CFP. Image size 2184x1682:
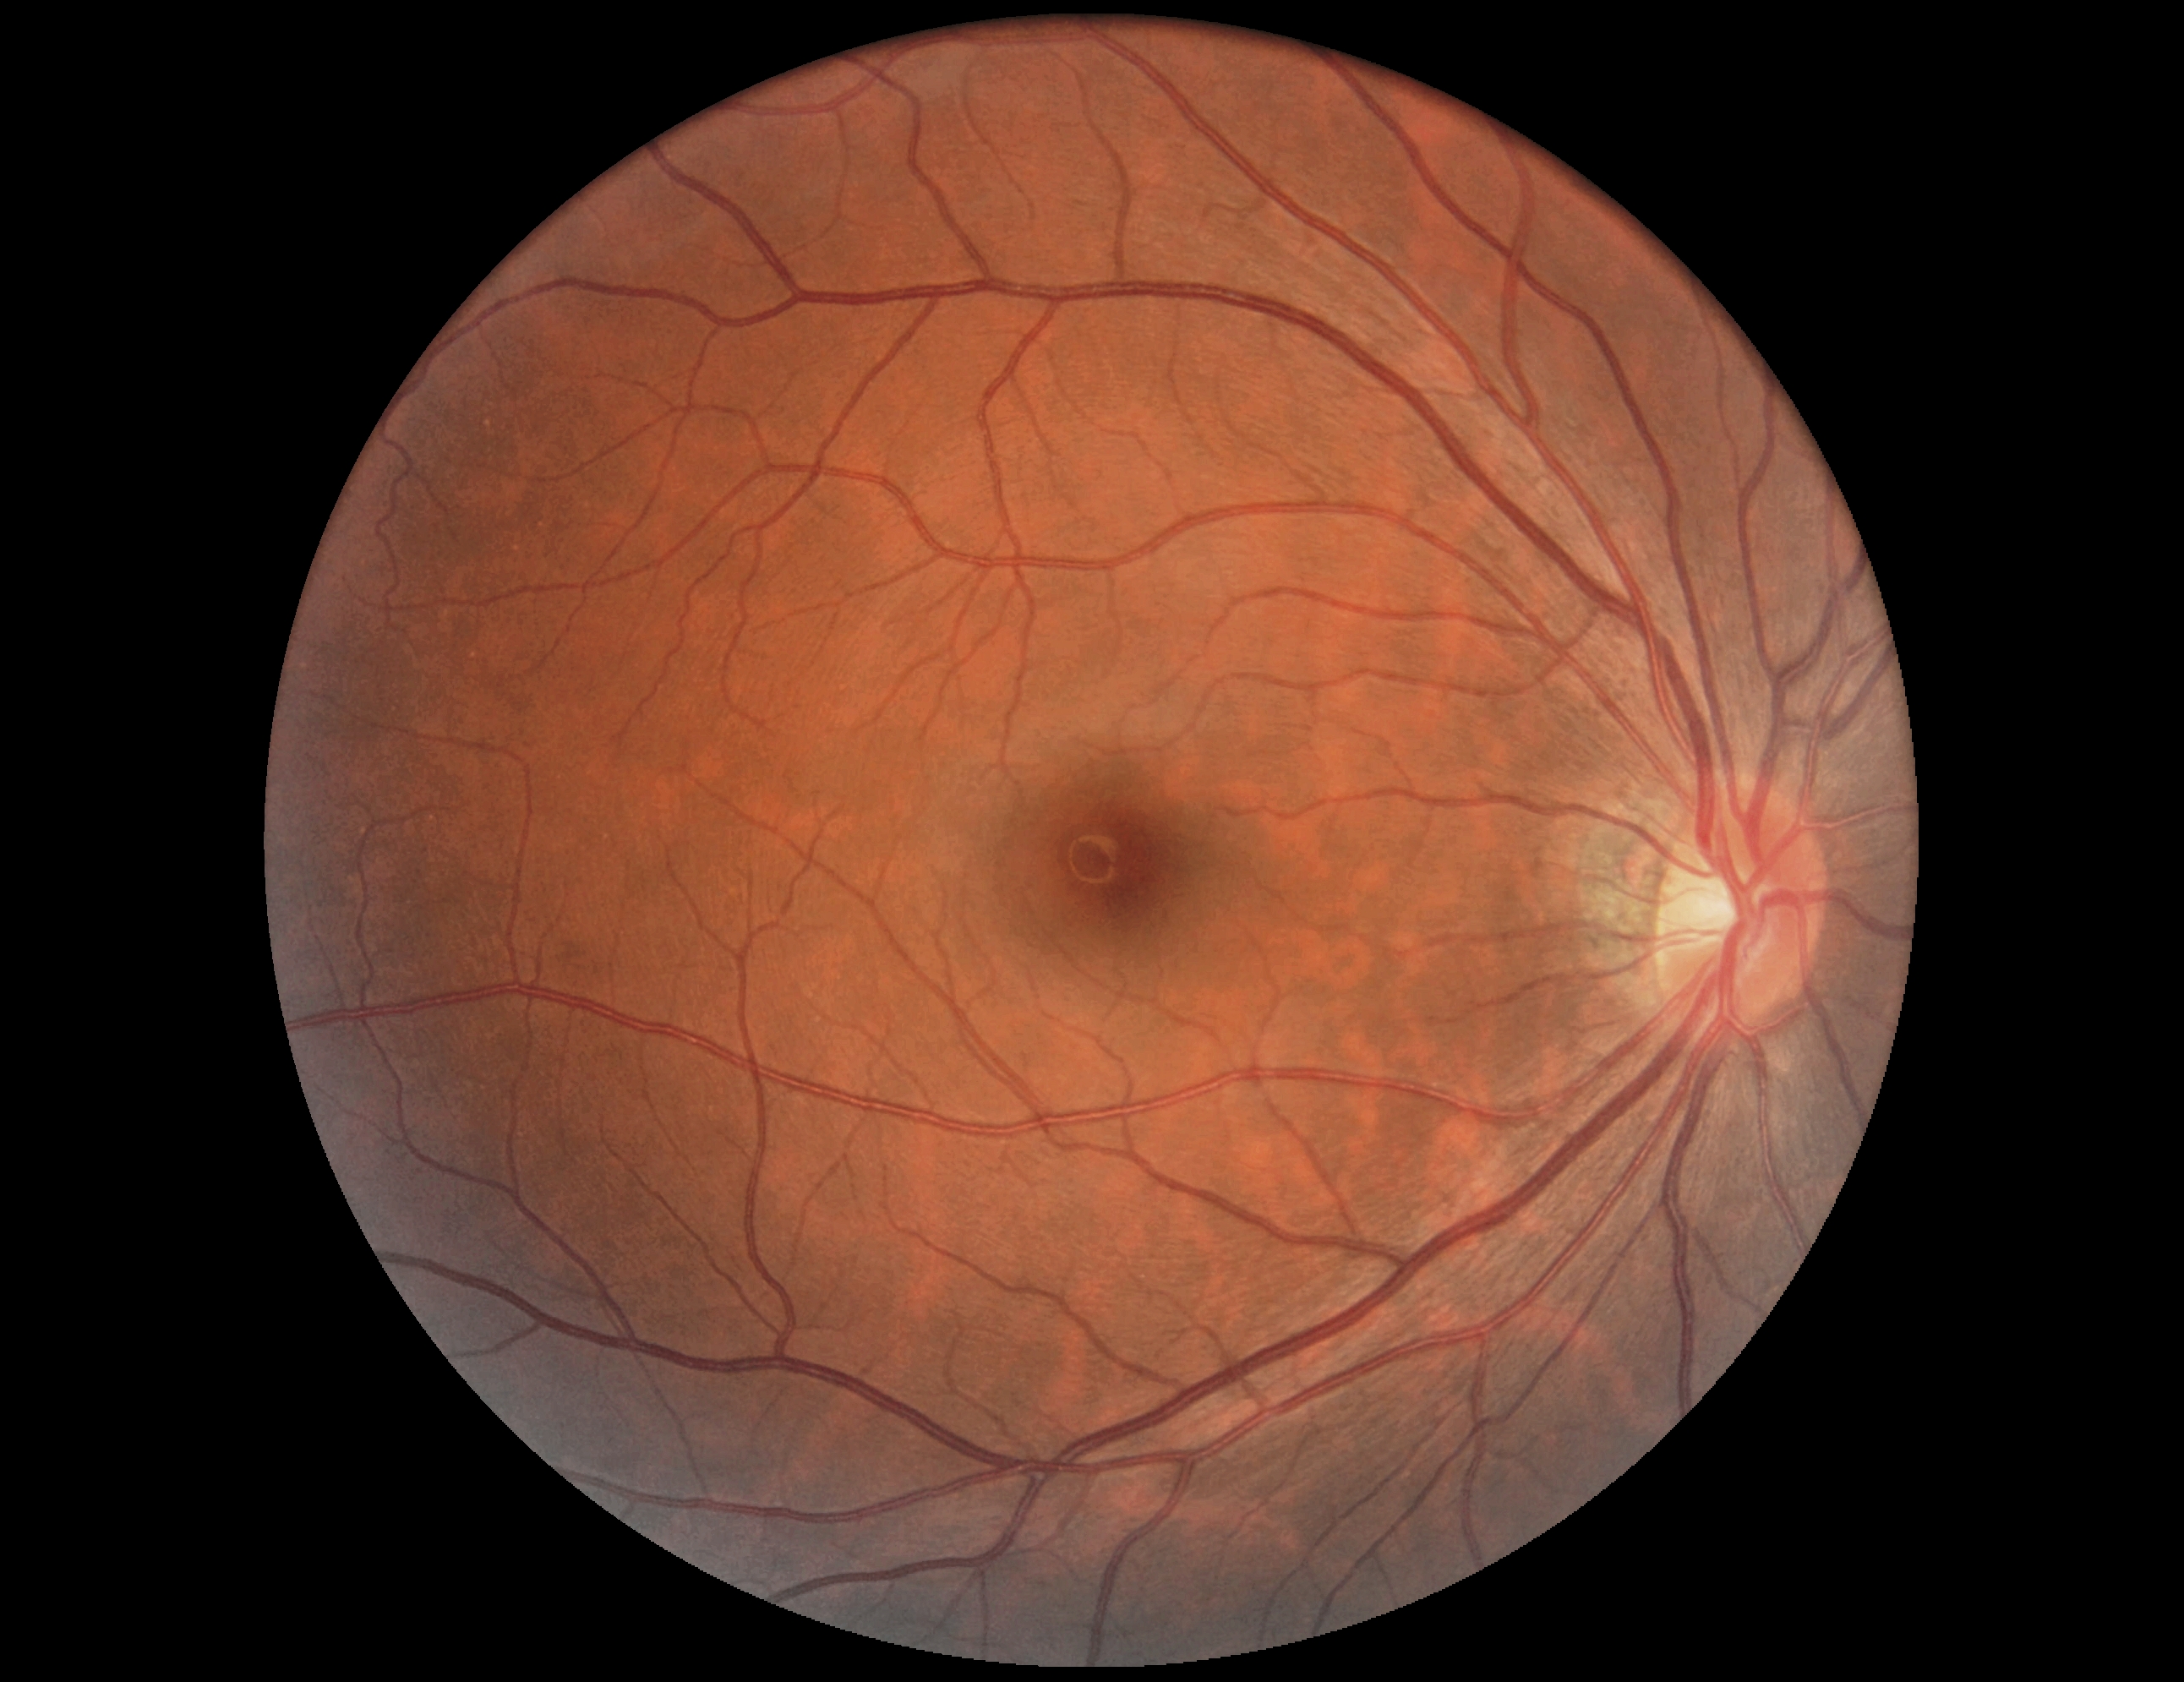 {"dr_impression": "no signs of DR", "dr_grade": "0/4"}